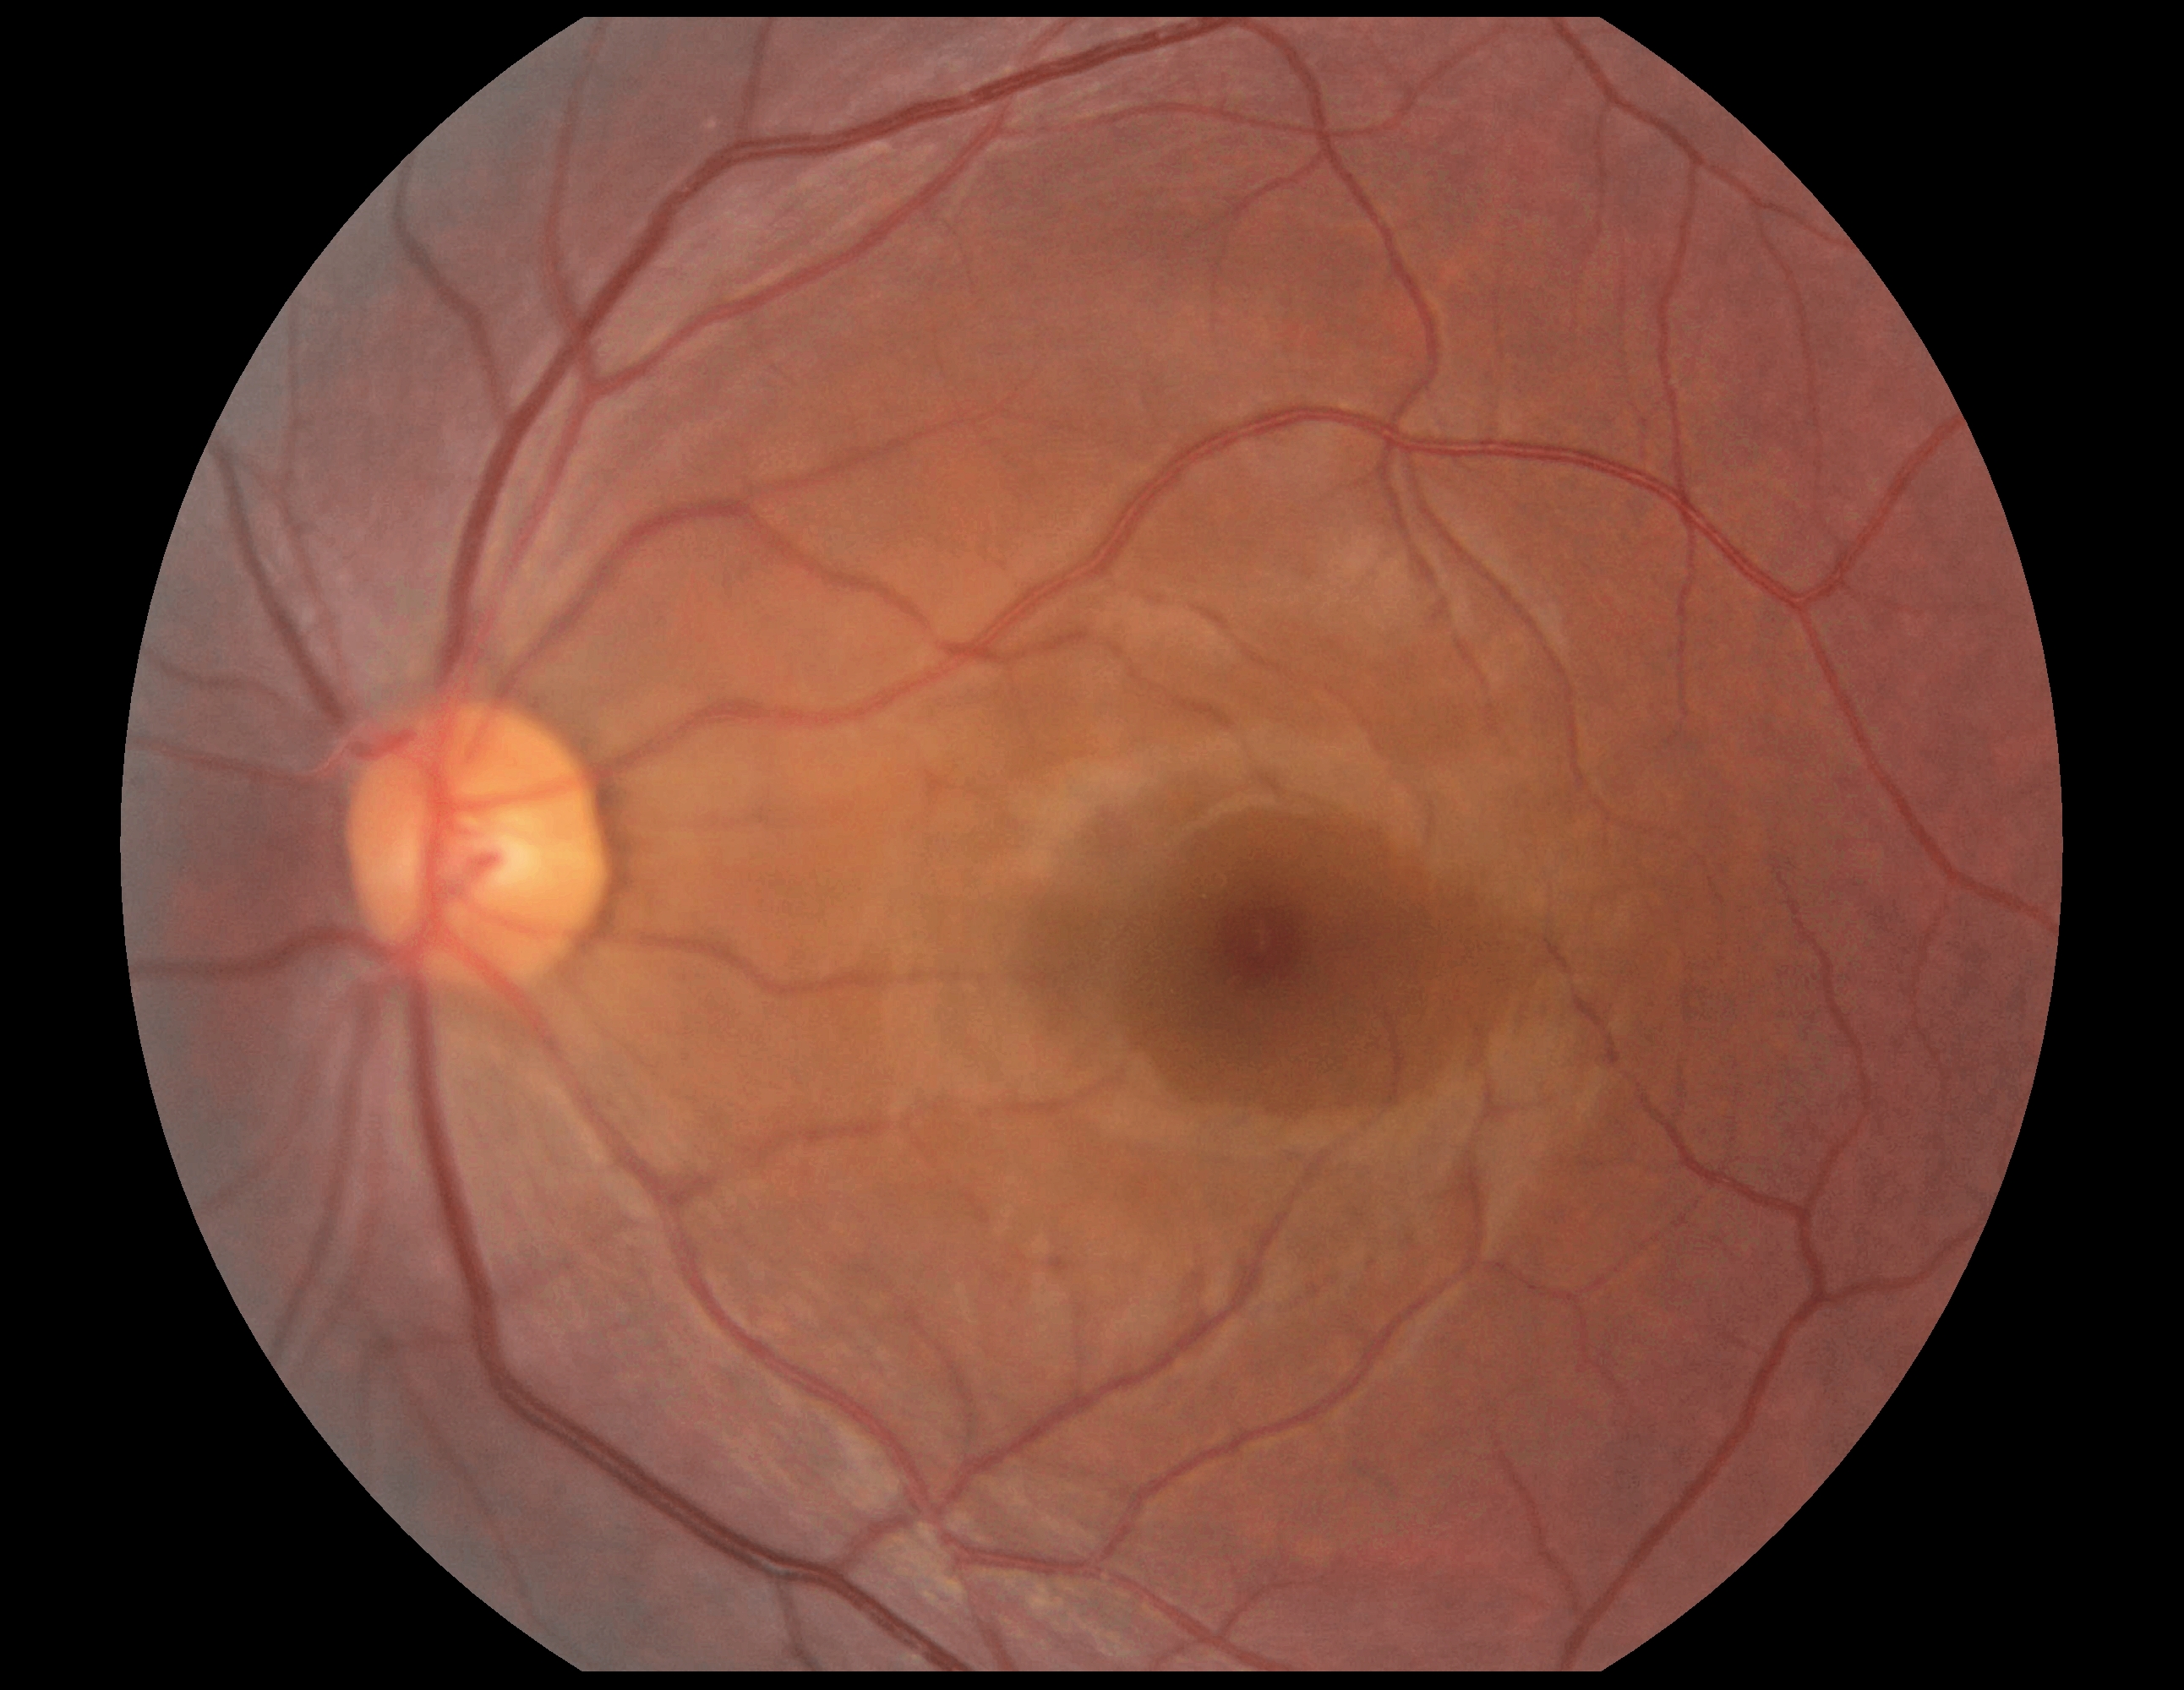
DR stage is grade 0 (no apparent retinopathy). No apparent diabetic retinopathy.